Infant wide-field retinal image; 130° field of view (Clarity RetCam 3) — 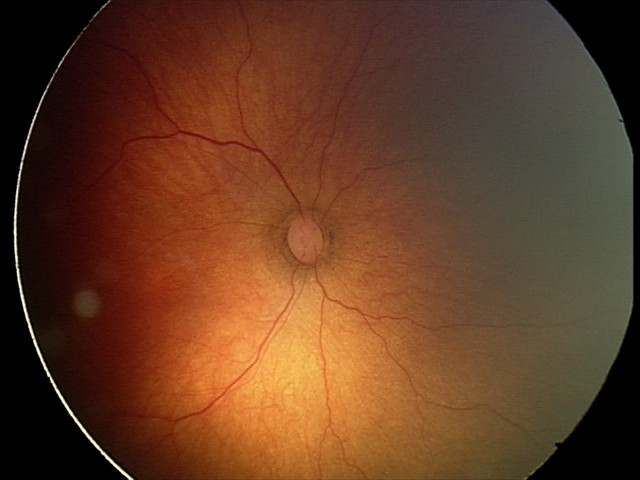 Diagnosis from this screening exam: retinopathy of prematurity (ROP) stage 2. Without plus disease.